RetCam wide-field infant fundus image · acquired on the Clarity RetCam 3 · 640x480:
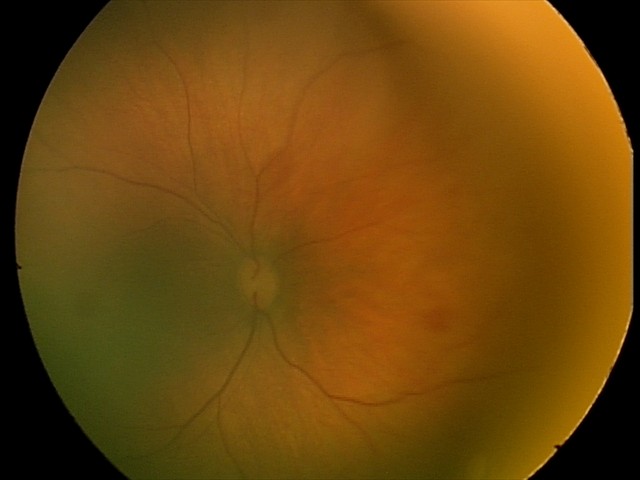

Finding = retinal hemorrhages.